2048x1536, CFP — 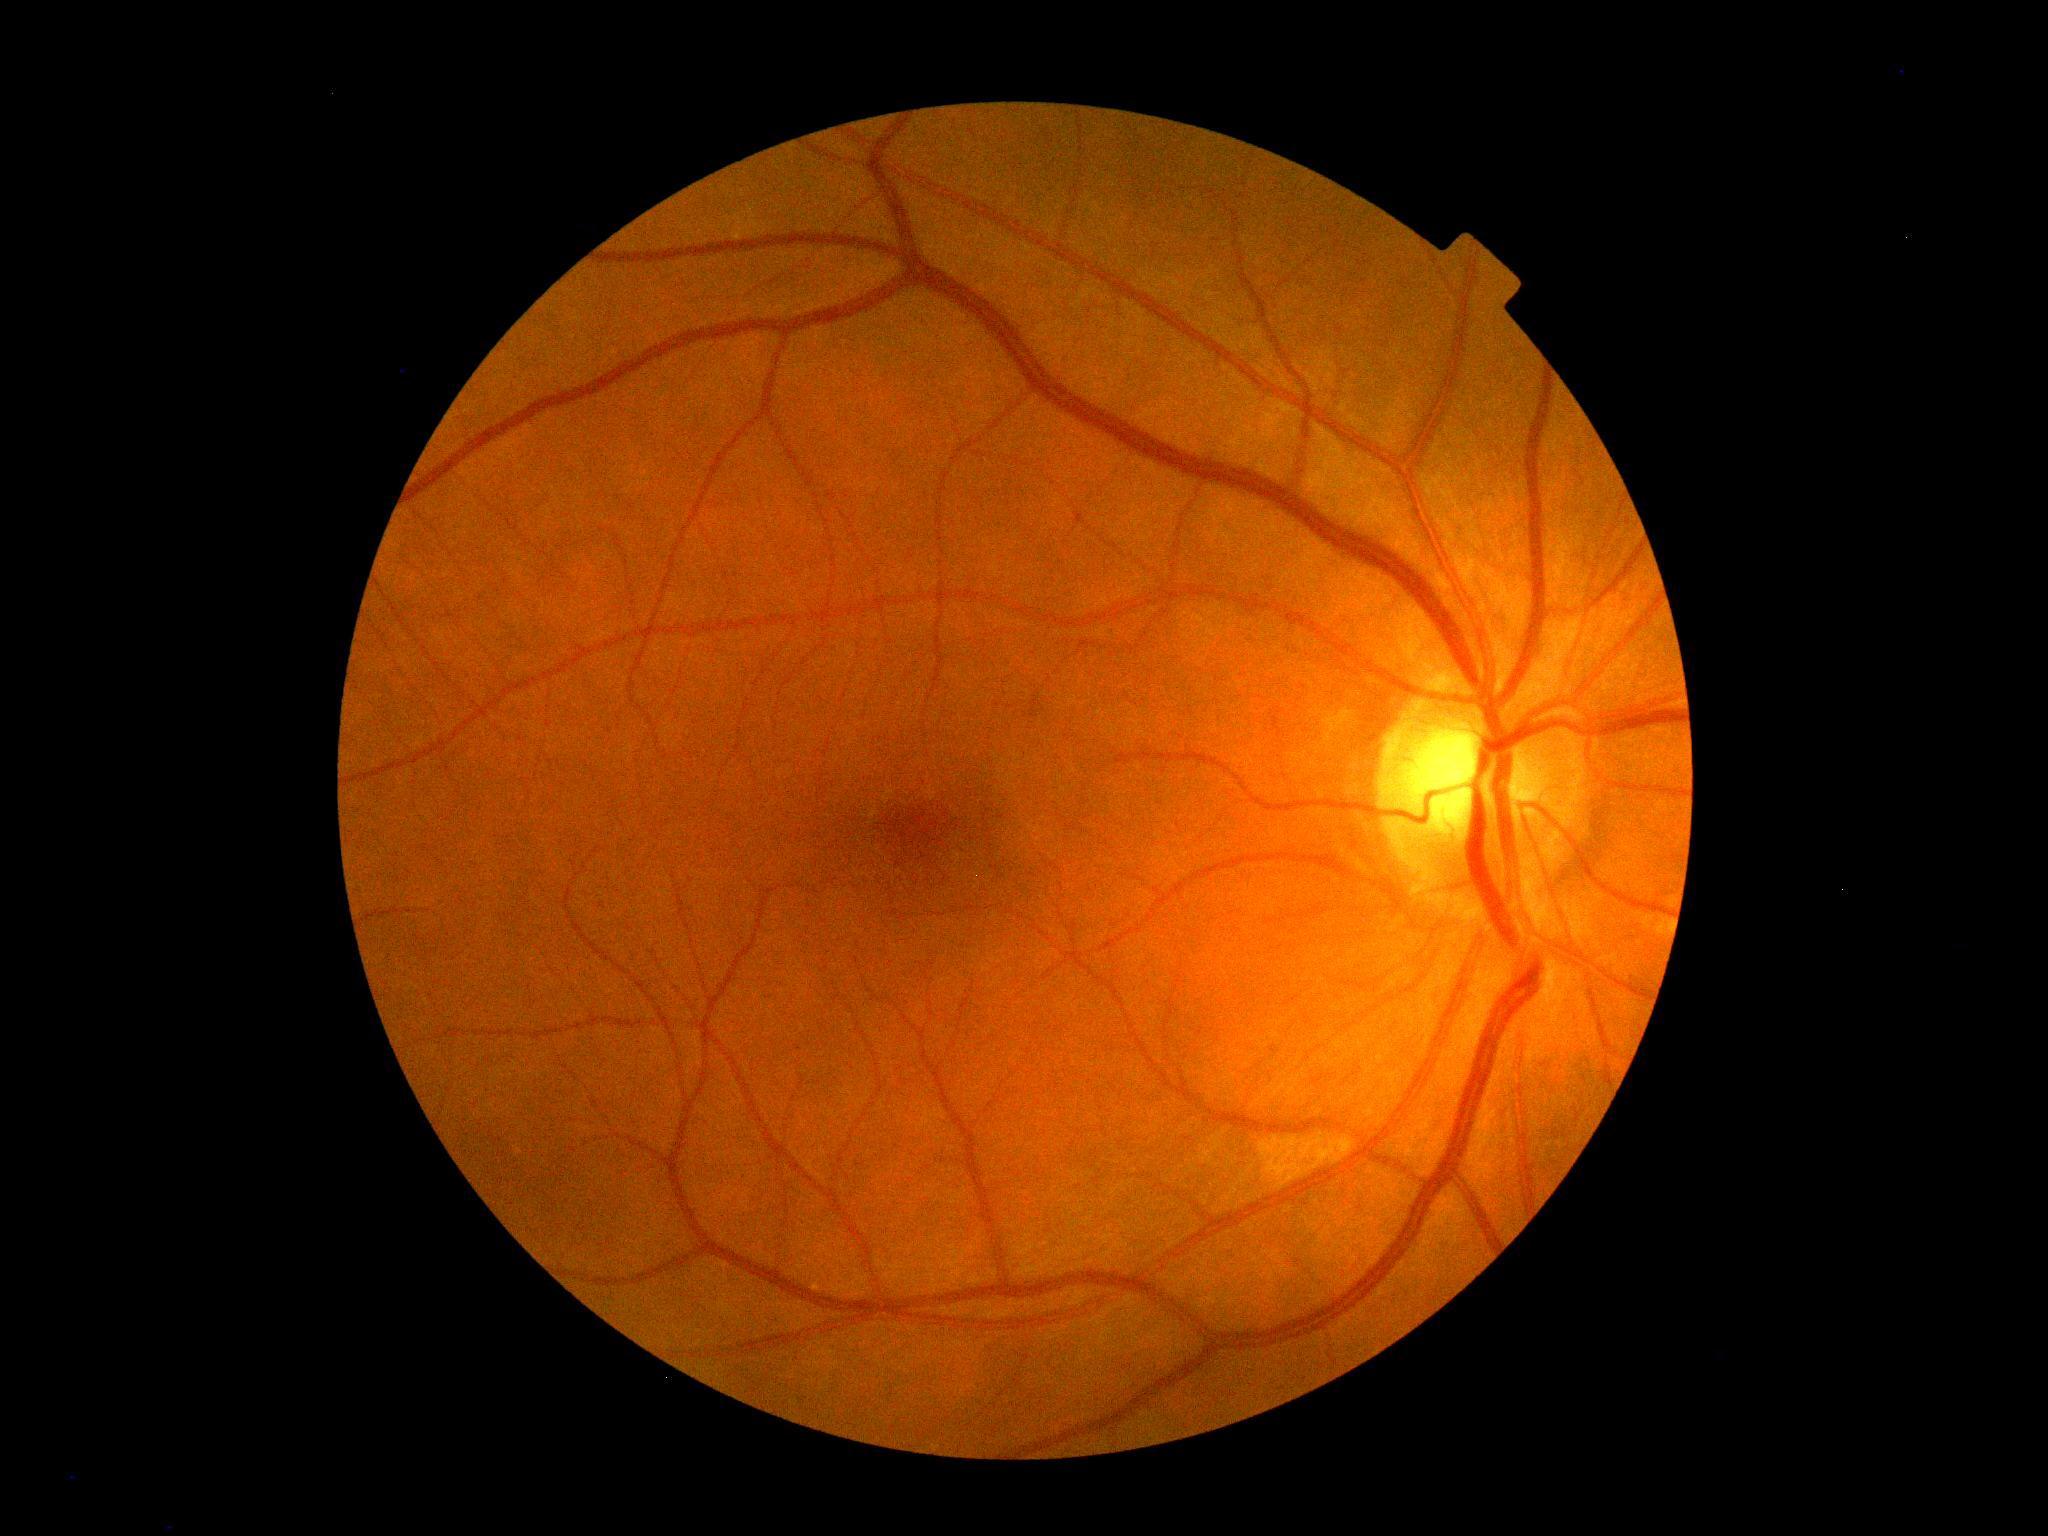

DR severity is 0/4. No DR findings.